Macula-centered, CFP.
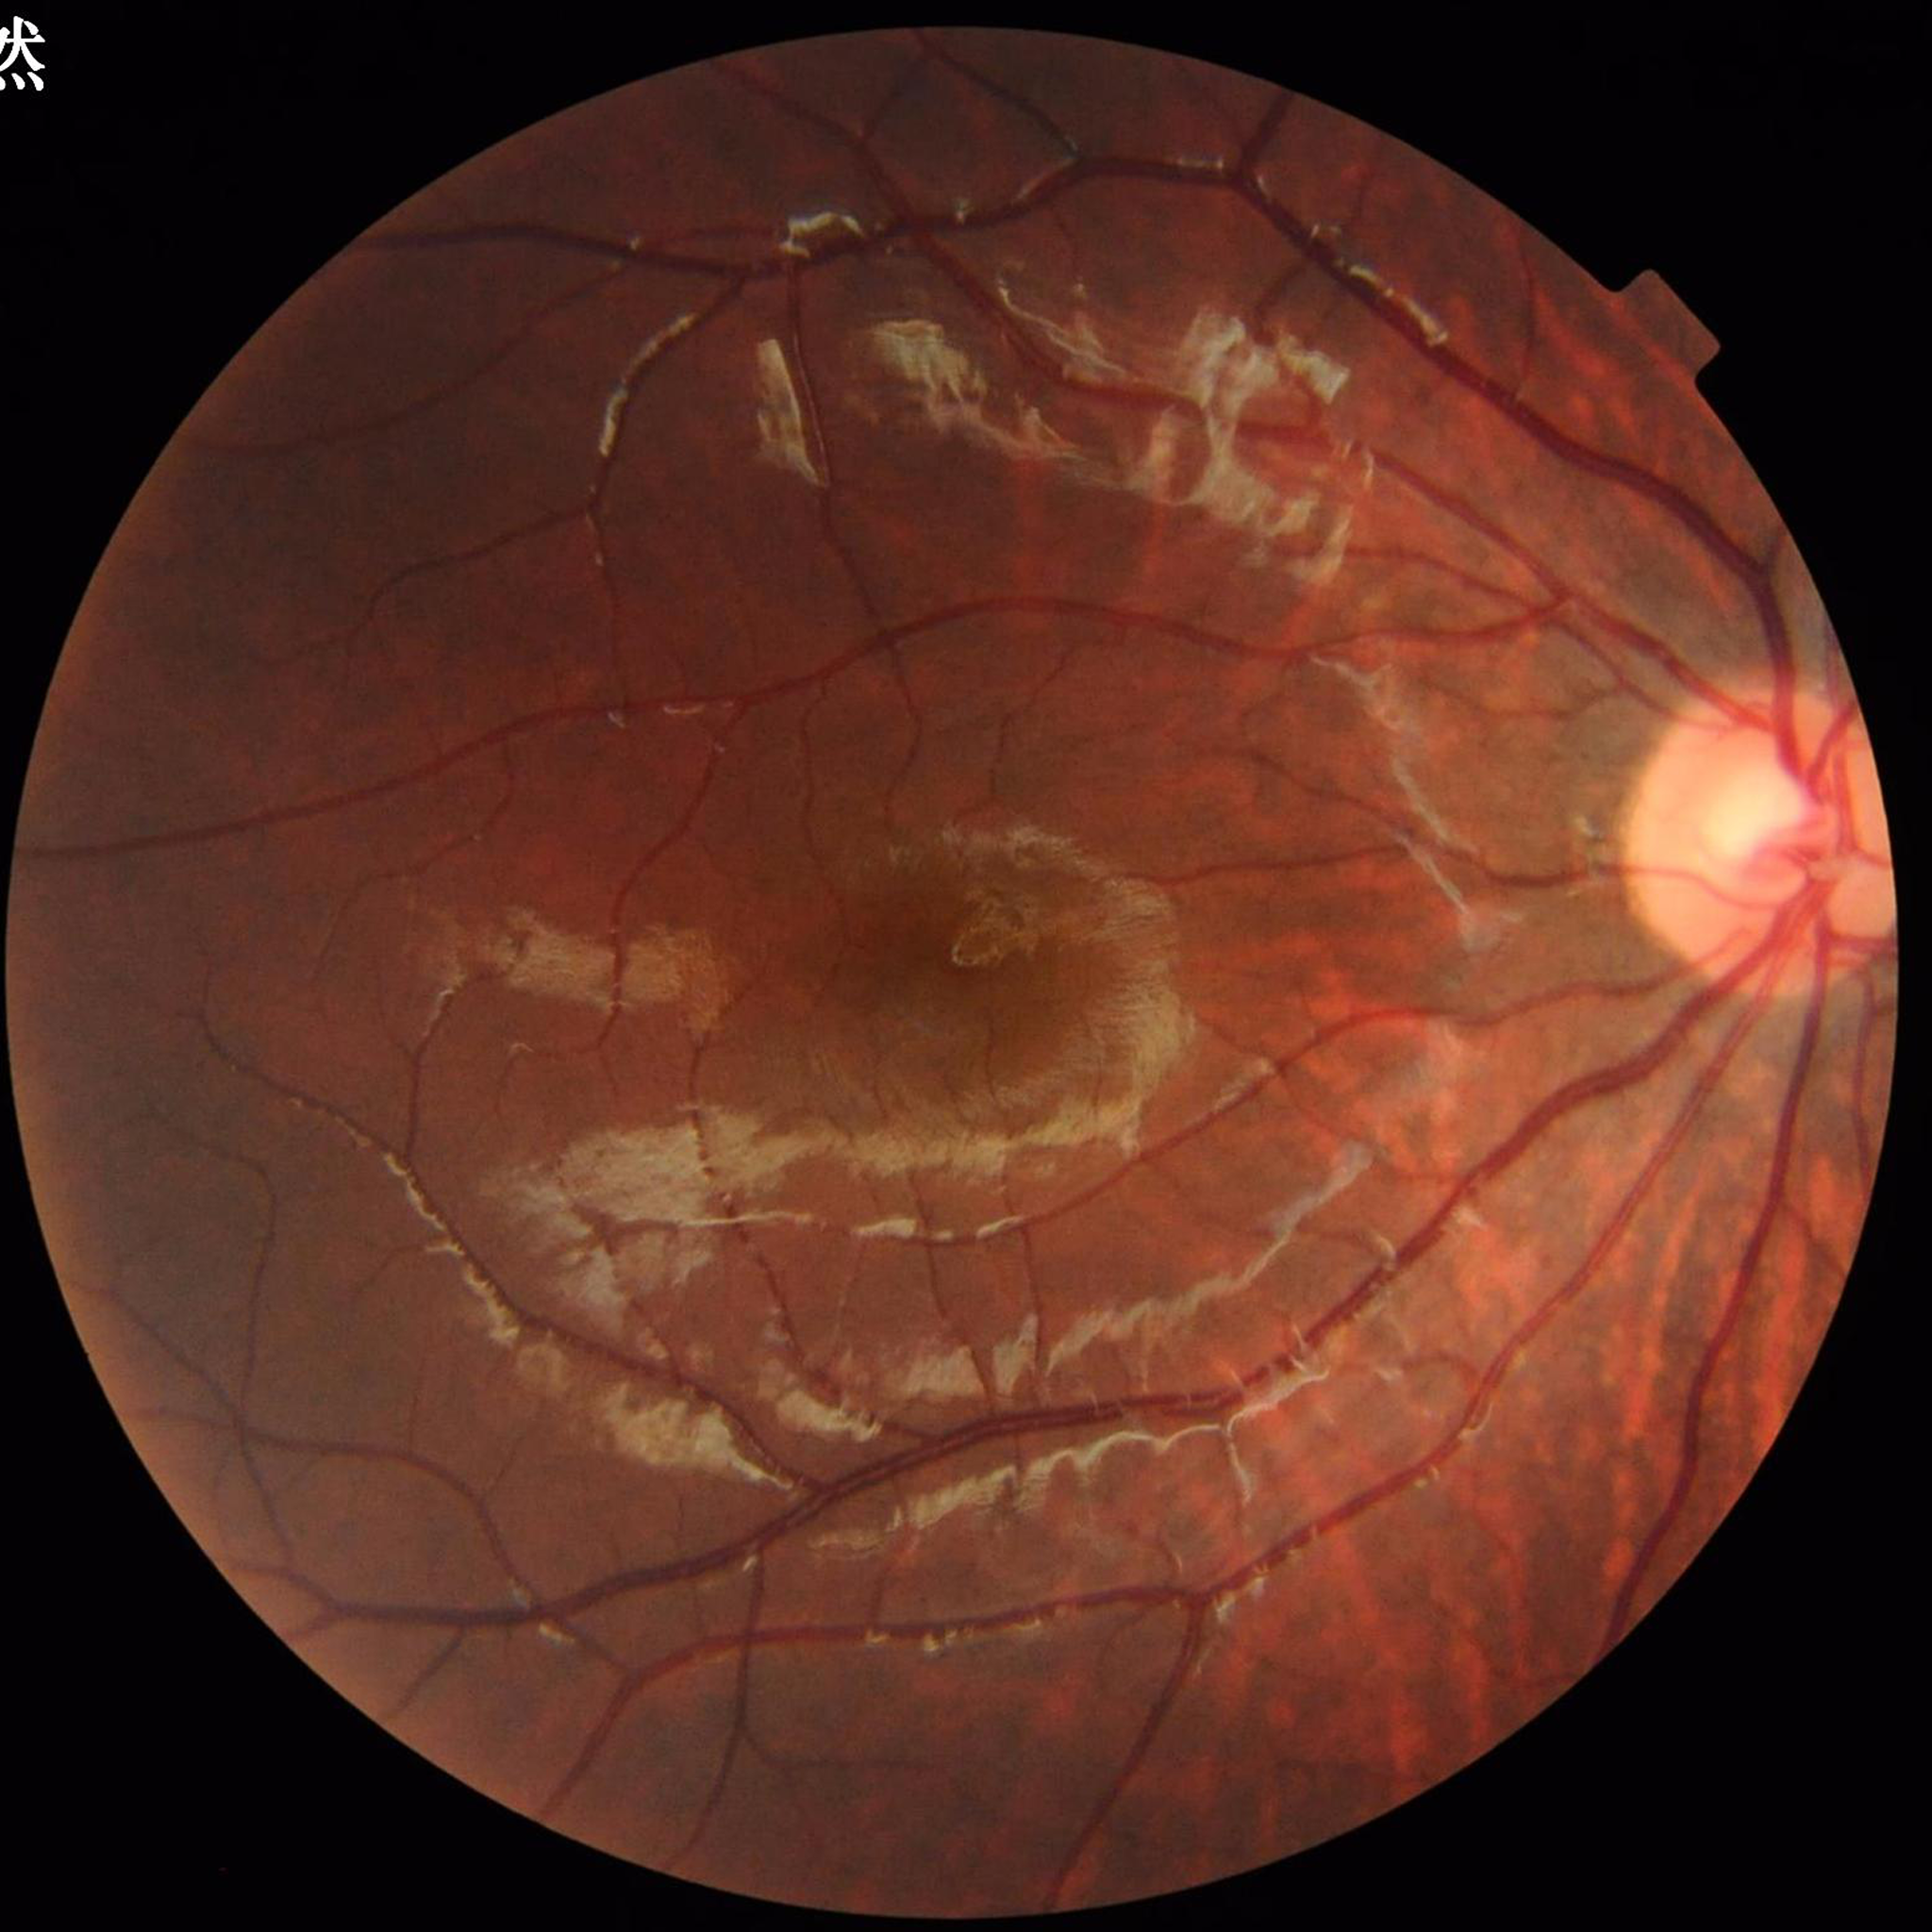

Image quality: satisfactory. No AMD, DR, or glaucomatous findings.